NIDEK AFC-230 fundus camera, 848x848px.
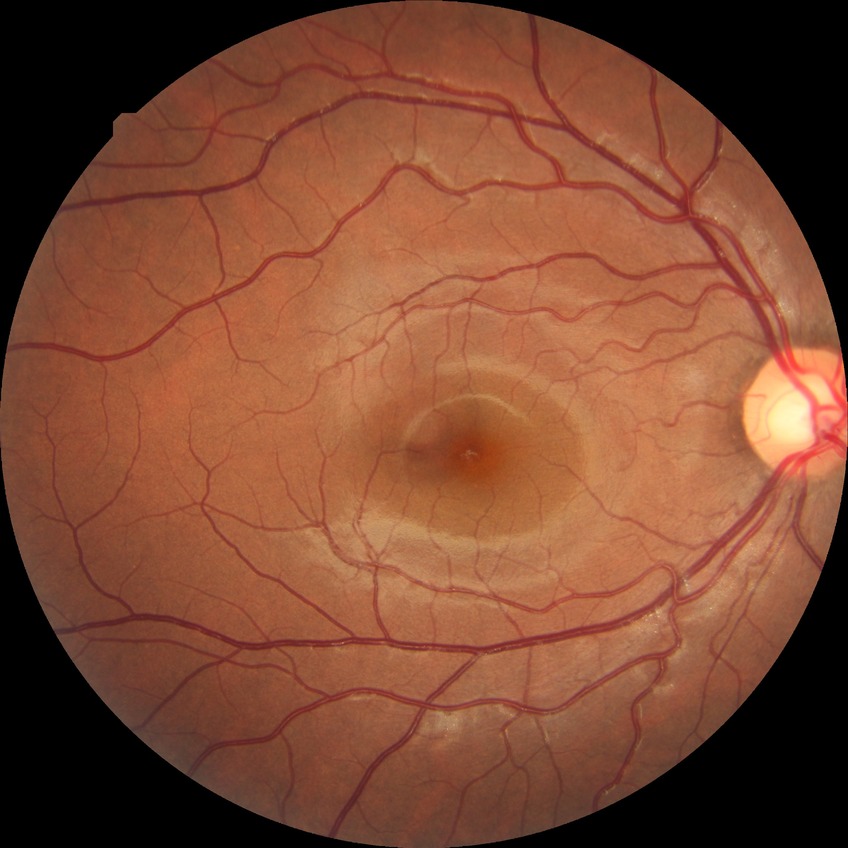
Diabetic retinopathy (DR): no diabetic retinopathy (NDR).